Wide-field contact fundus photograph of an infant. 1240x1240px
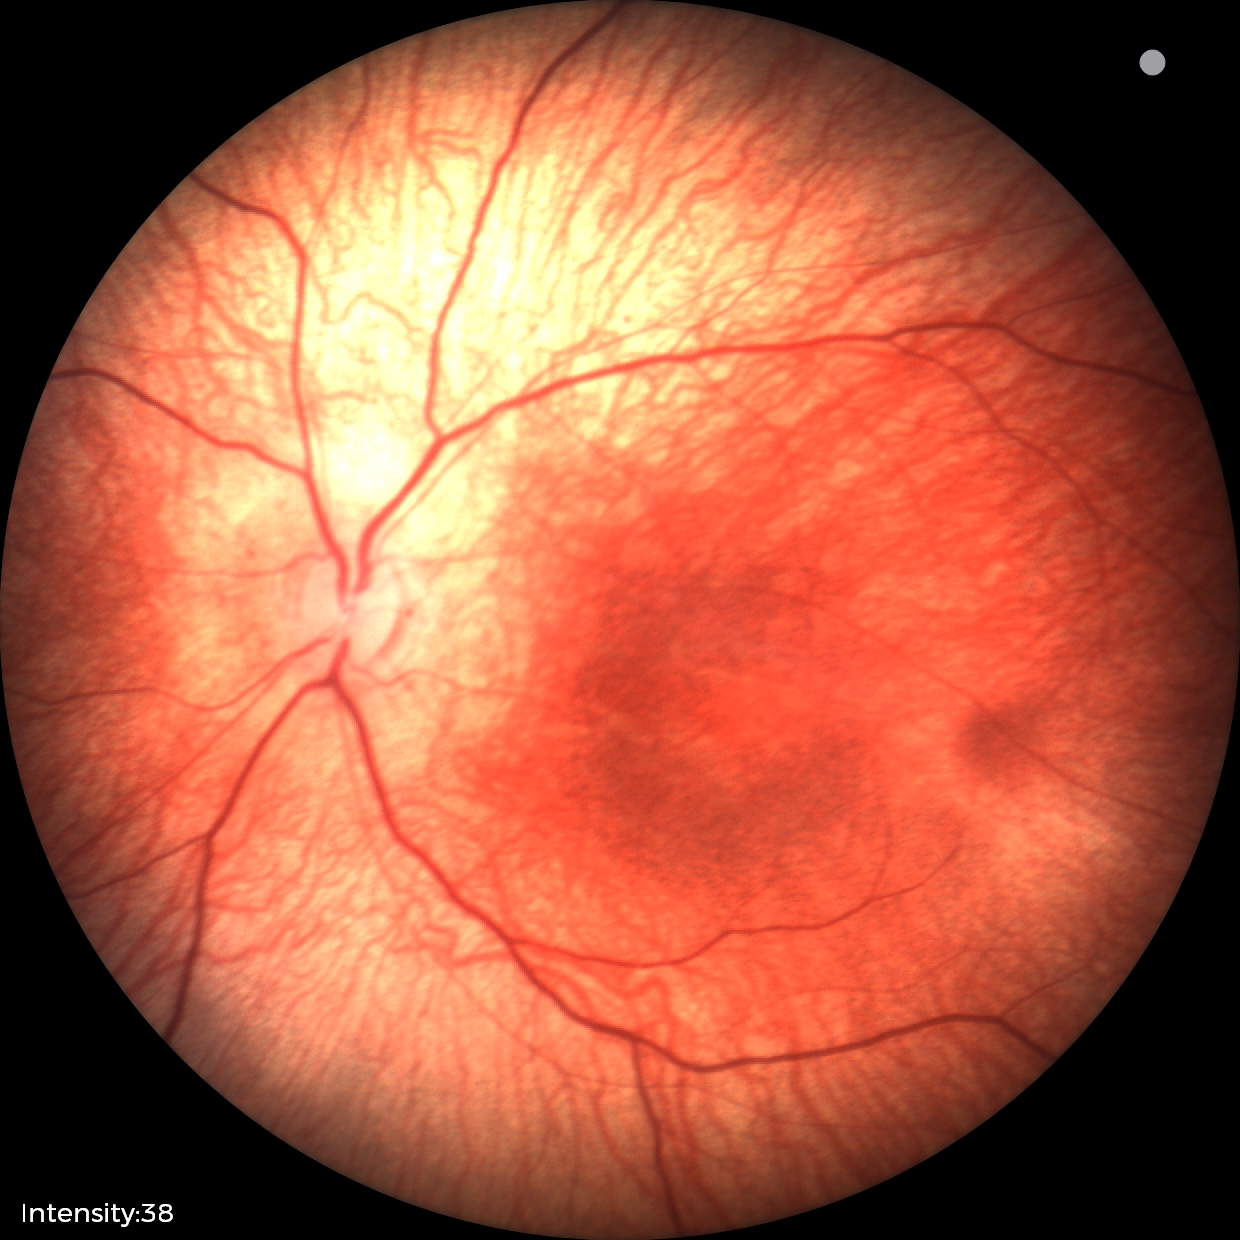
Normal screening examination.